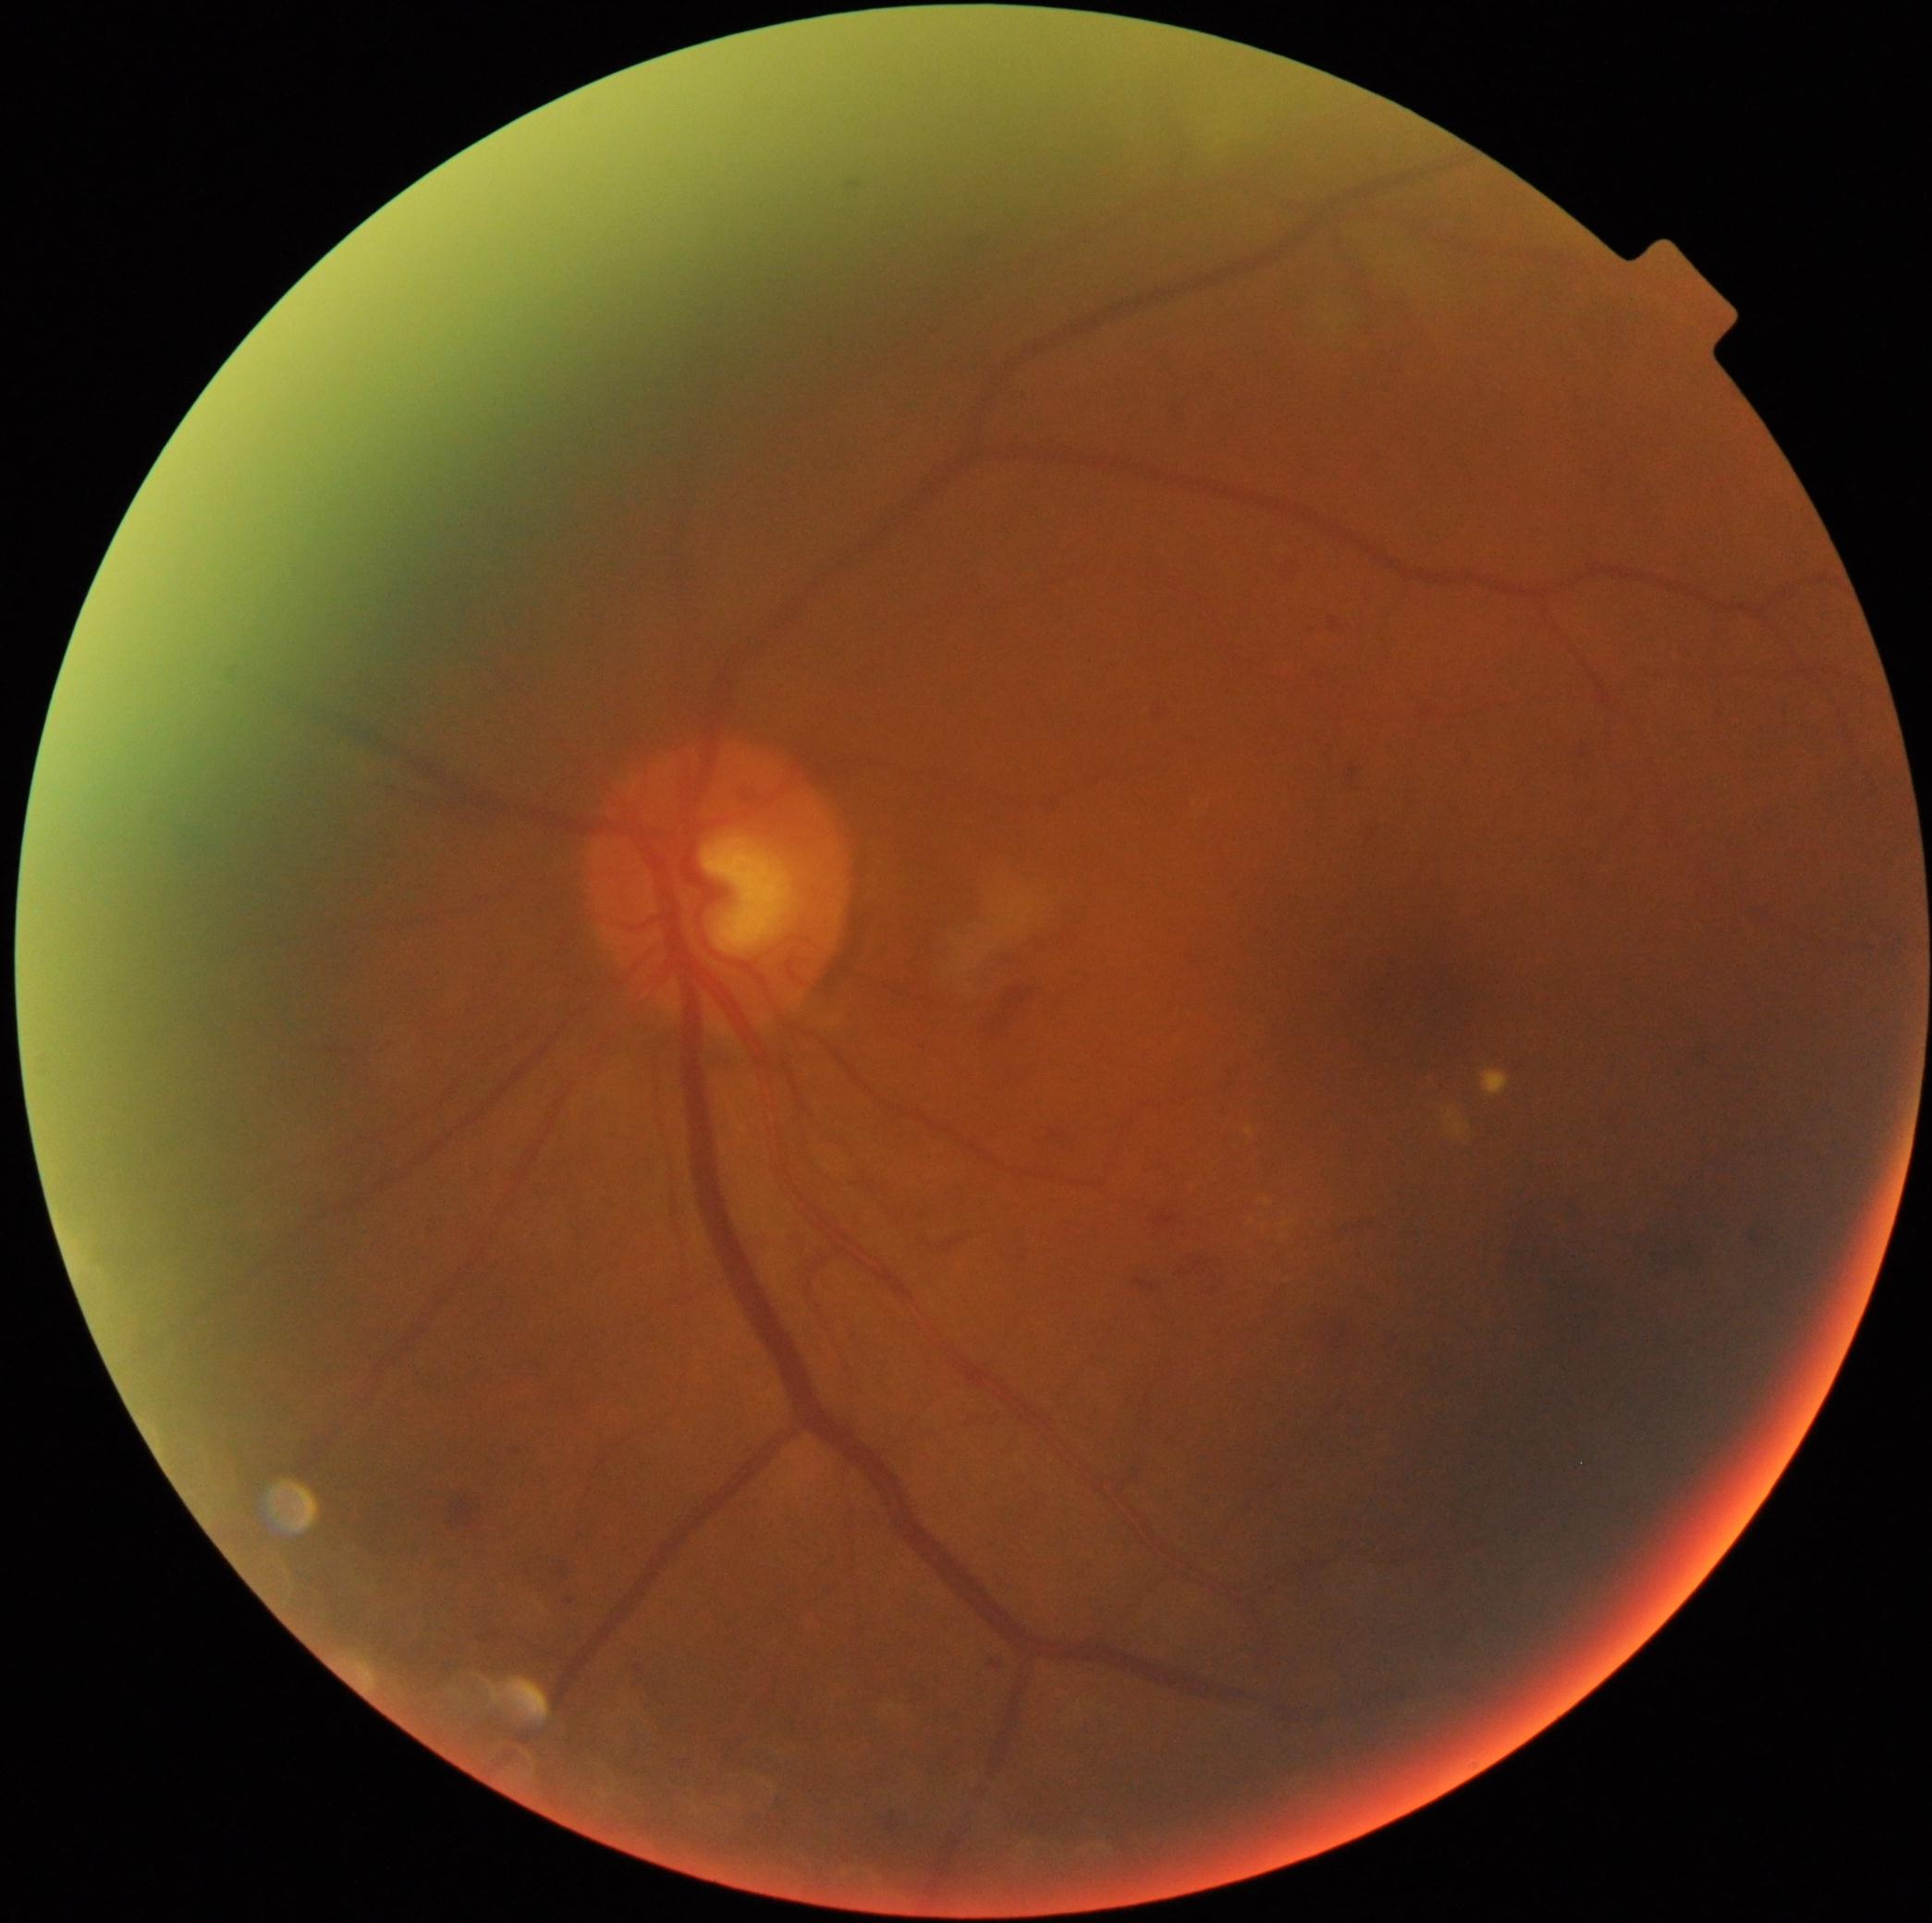

Annotations:
* DR — grade 2 (moderate NPDR)